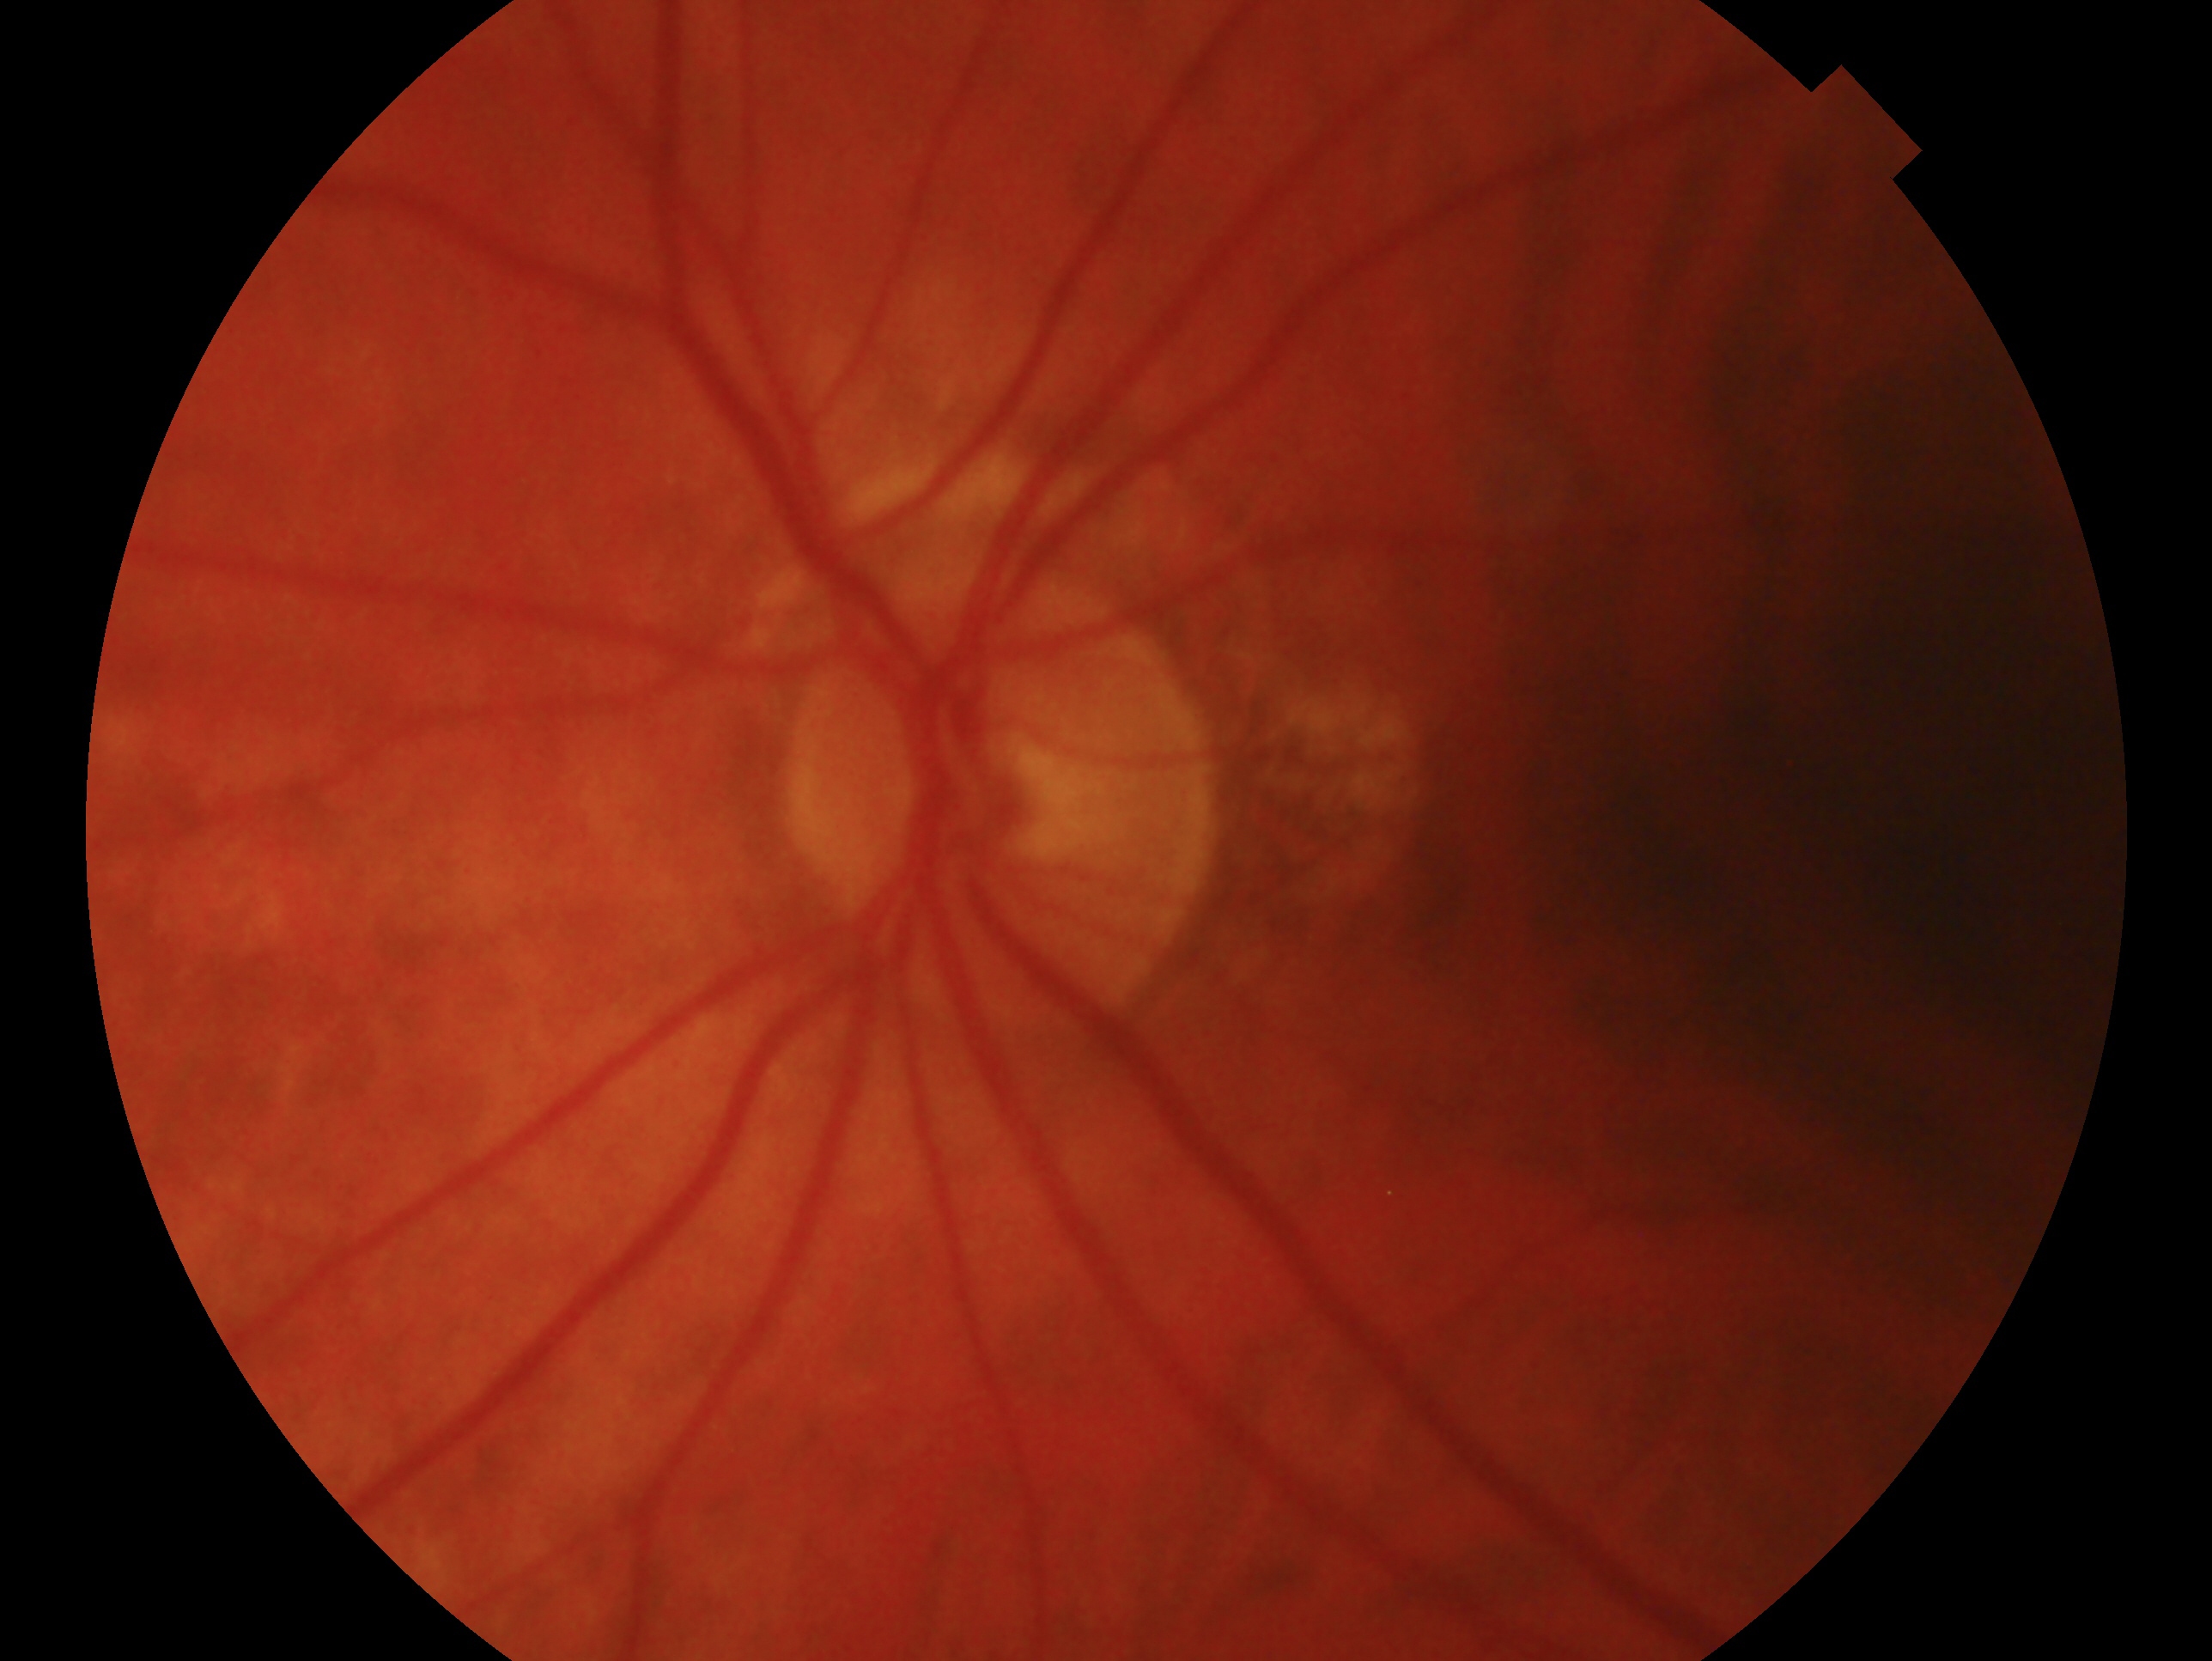 laterality: left eye; glaucoma status: negative for glaucoma.